2352 x 1568 pixels — 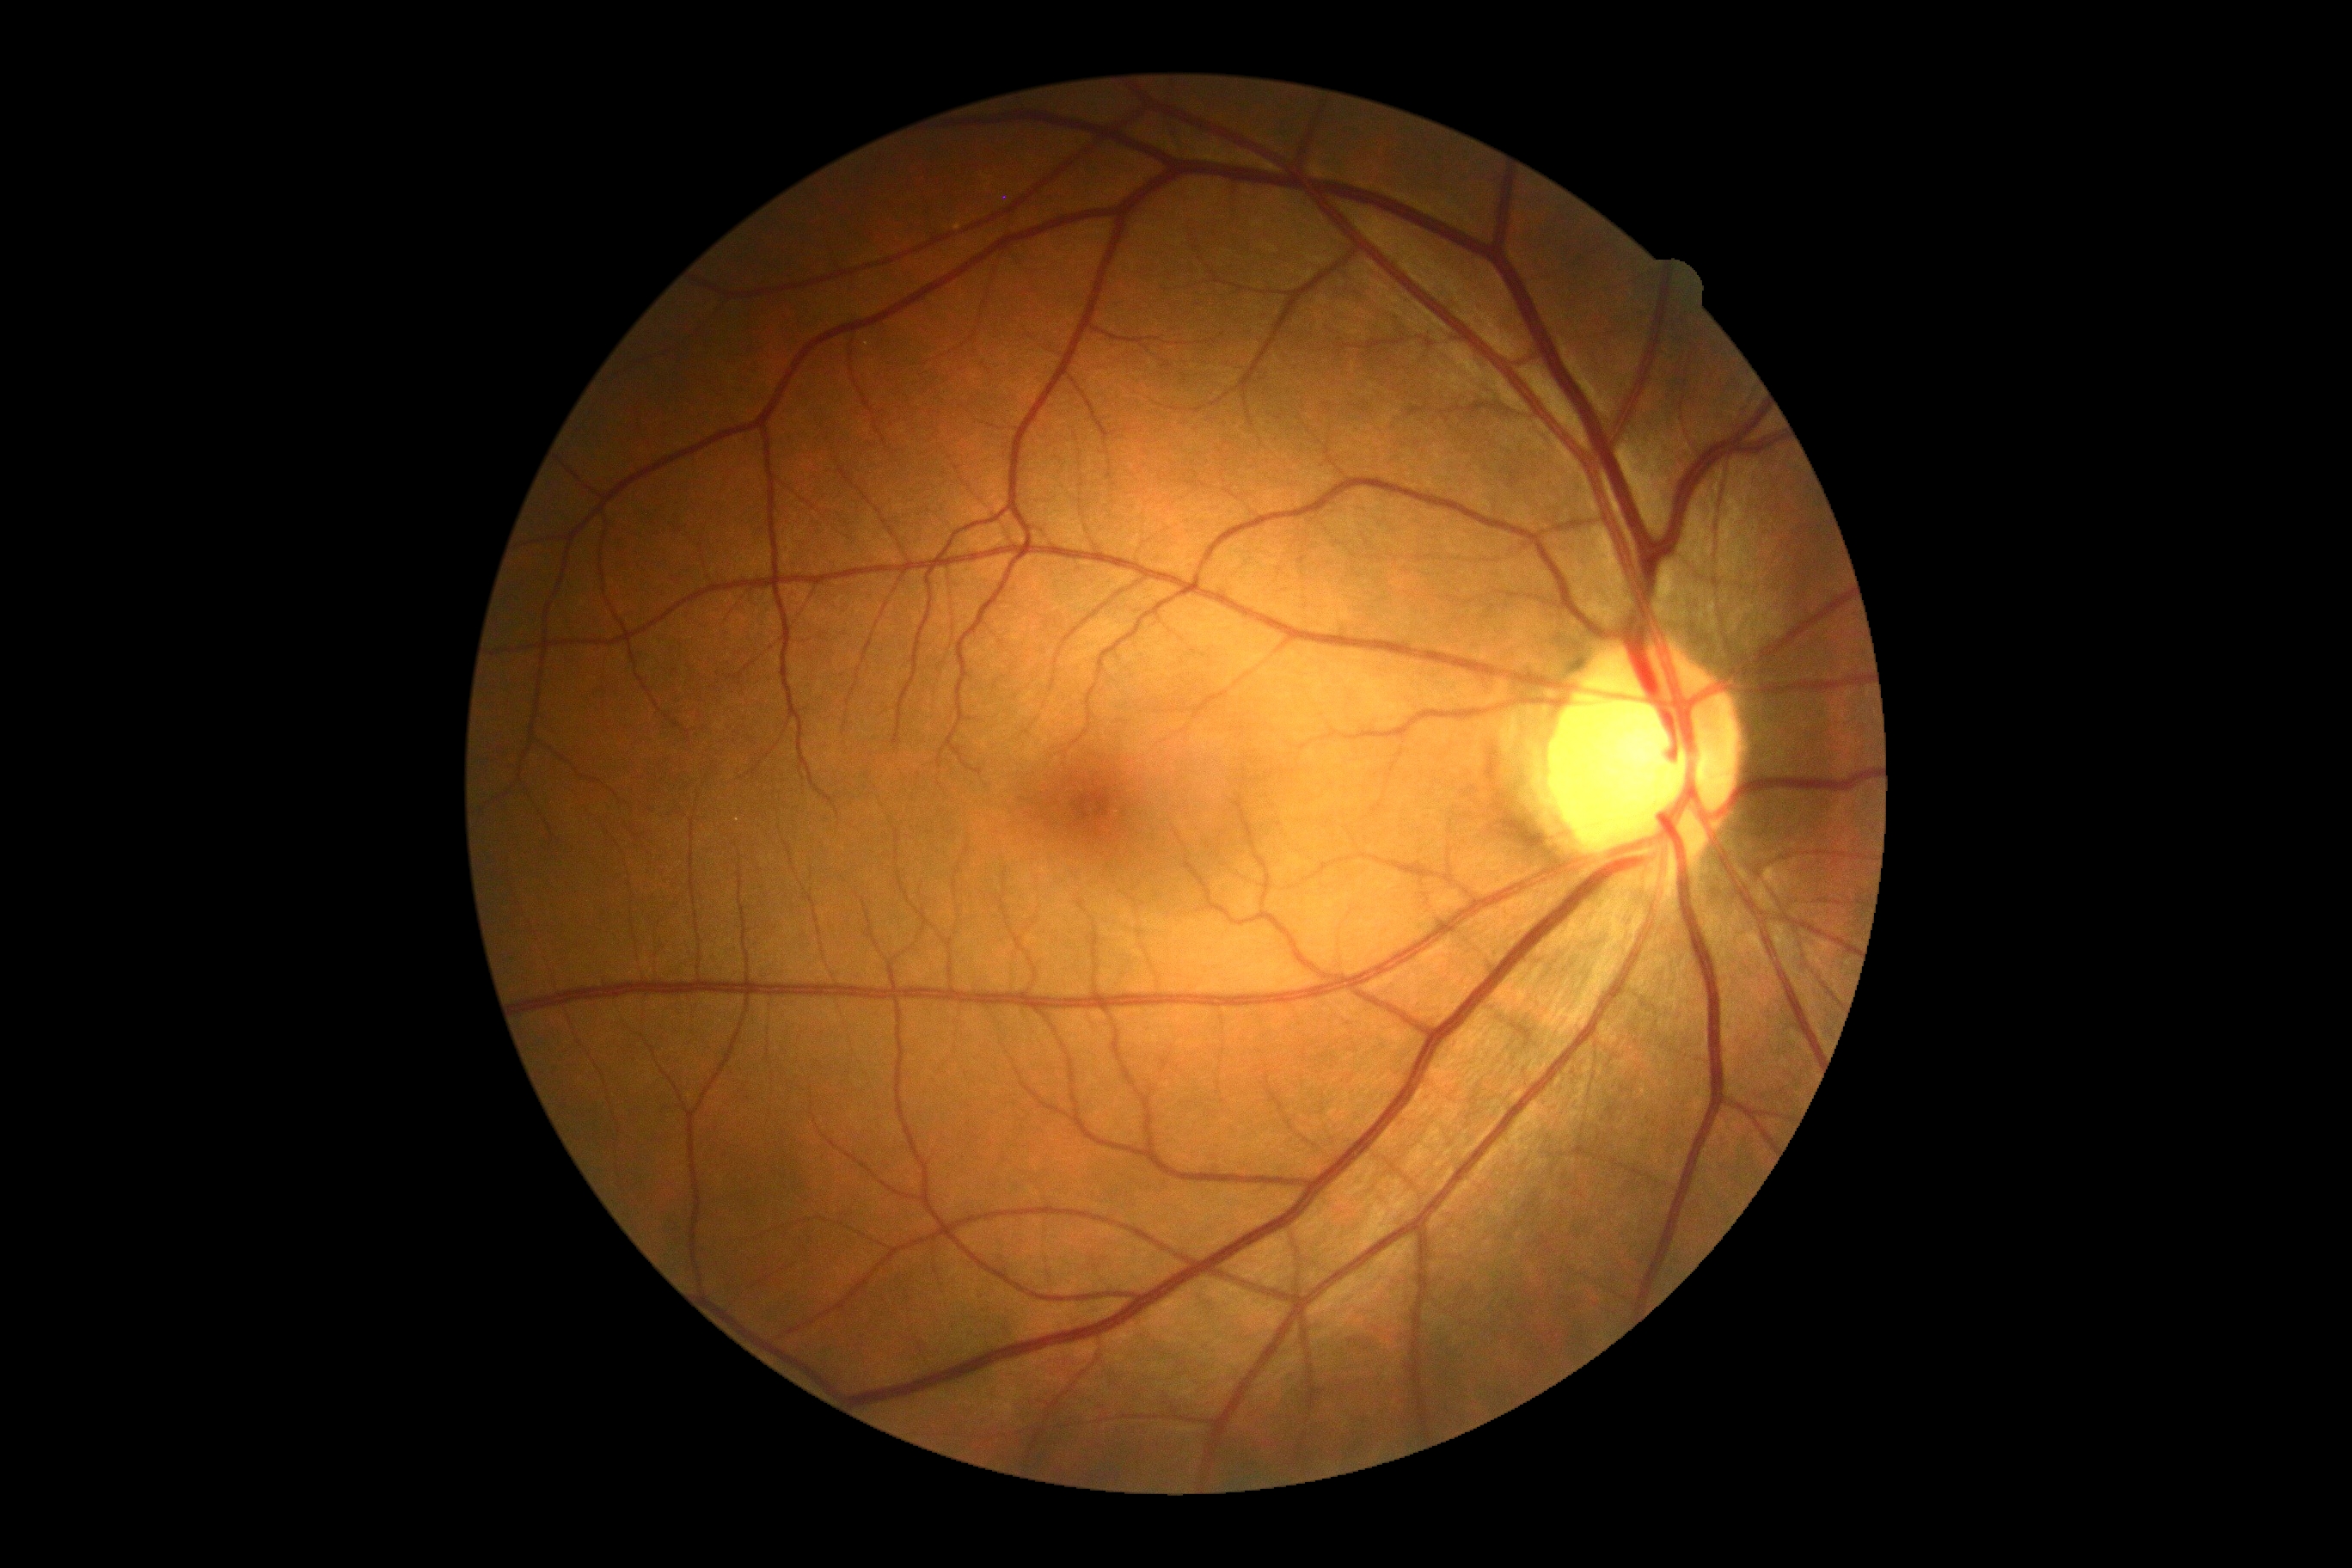

Annotations:
– DR impression — no DR findings
– diabetic retinopathy severity — no apparent retinopathy (grade 0)